Camera: Remidio smartphone fundus camera.
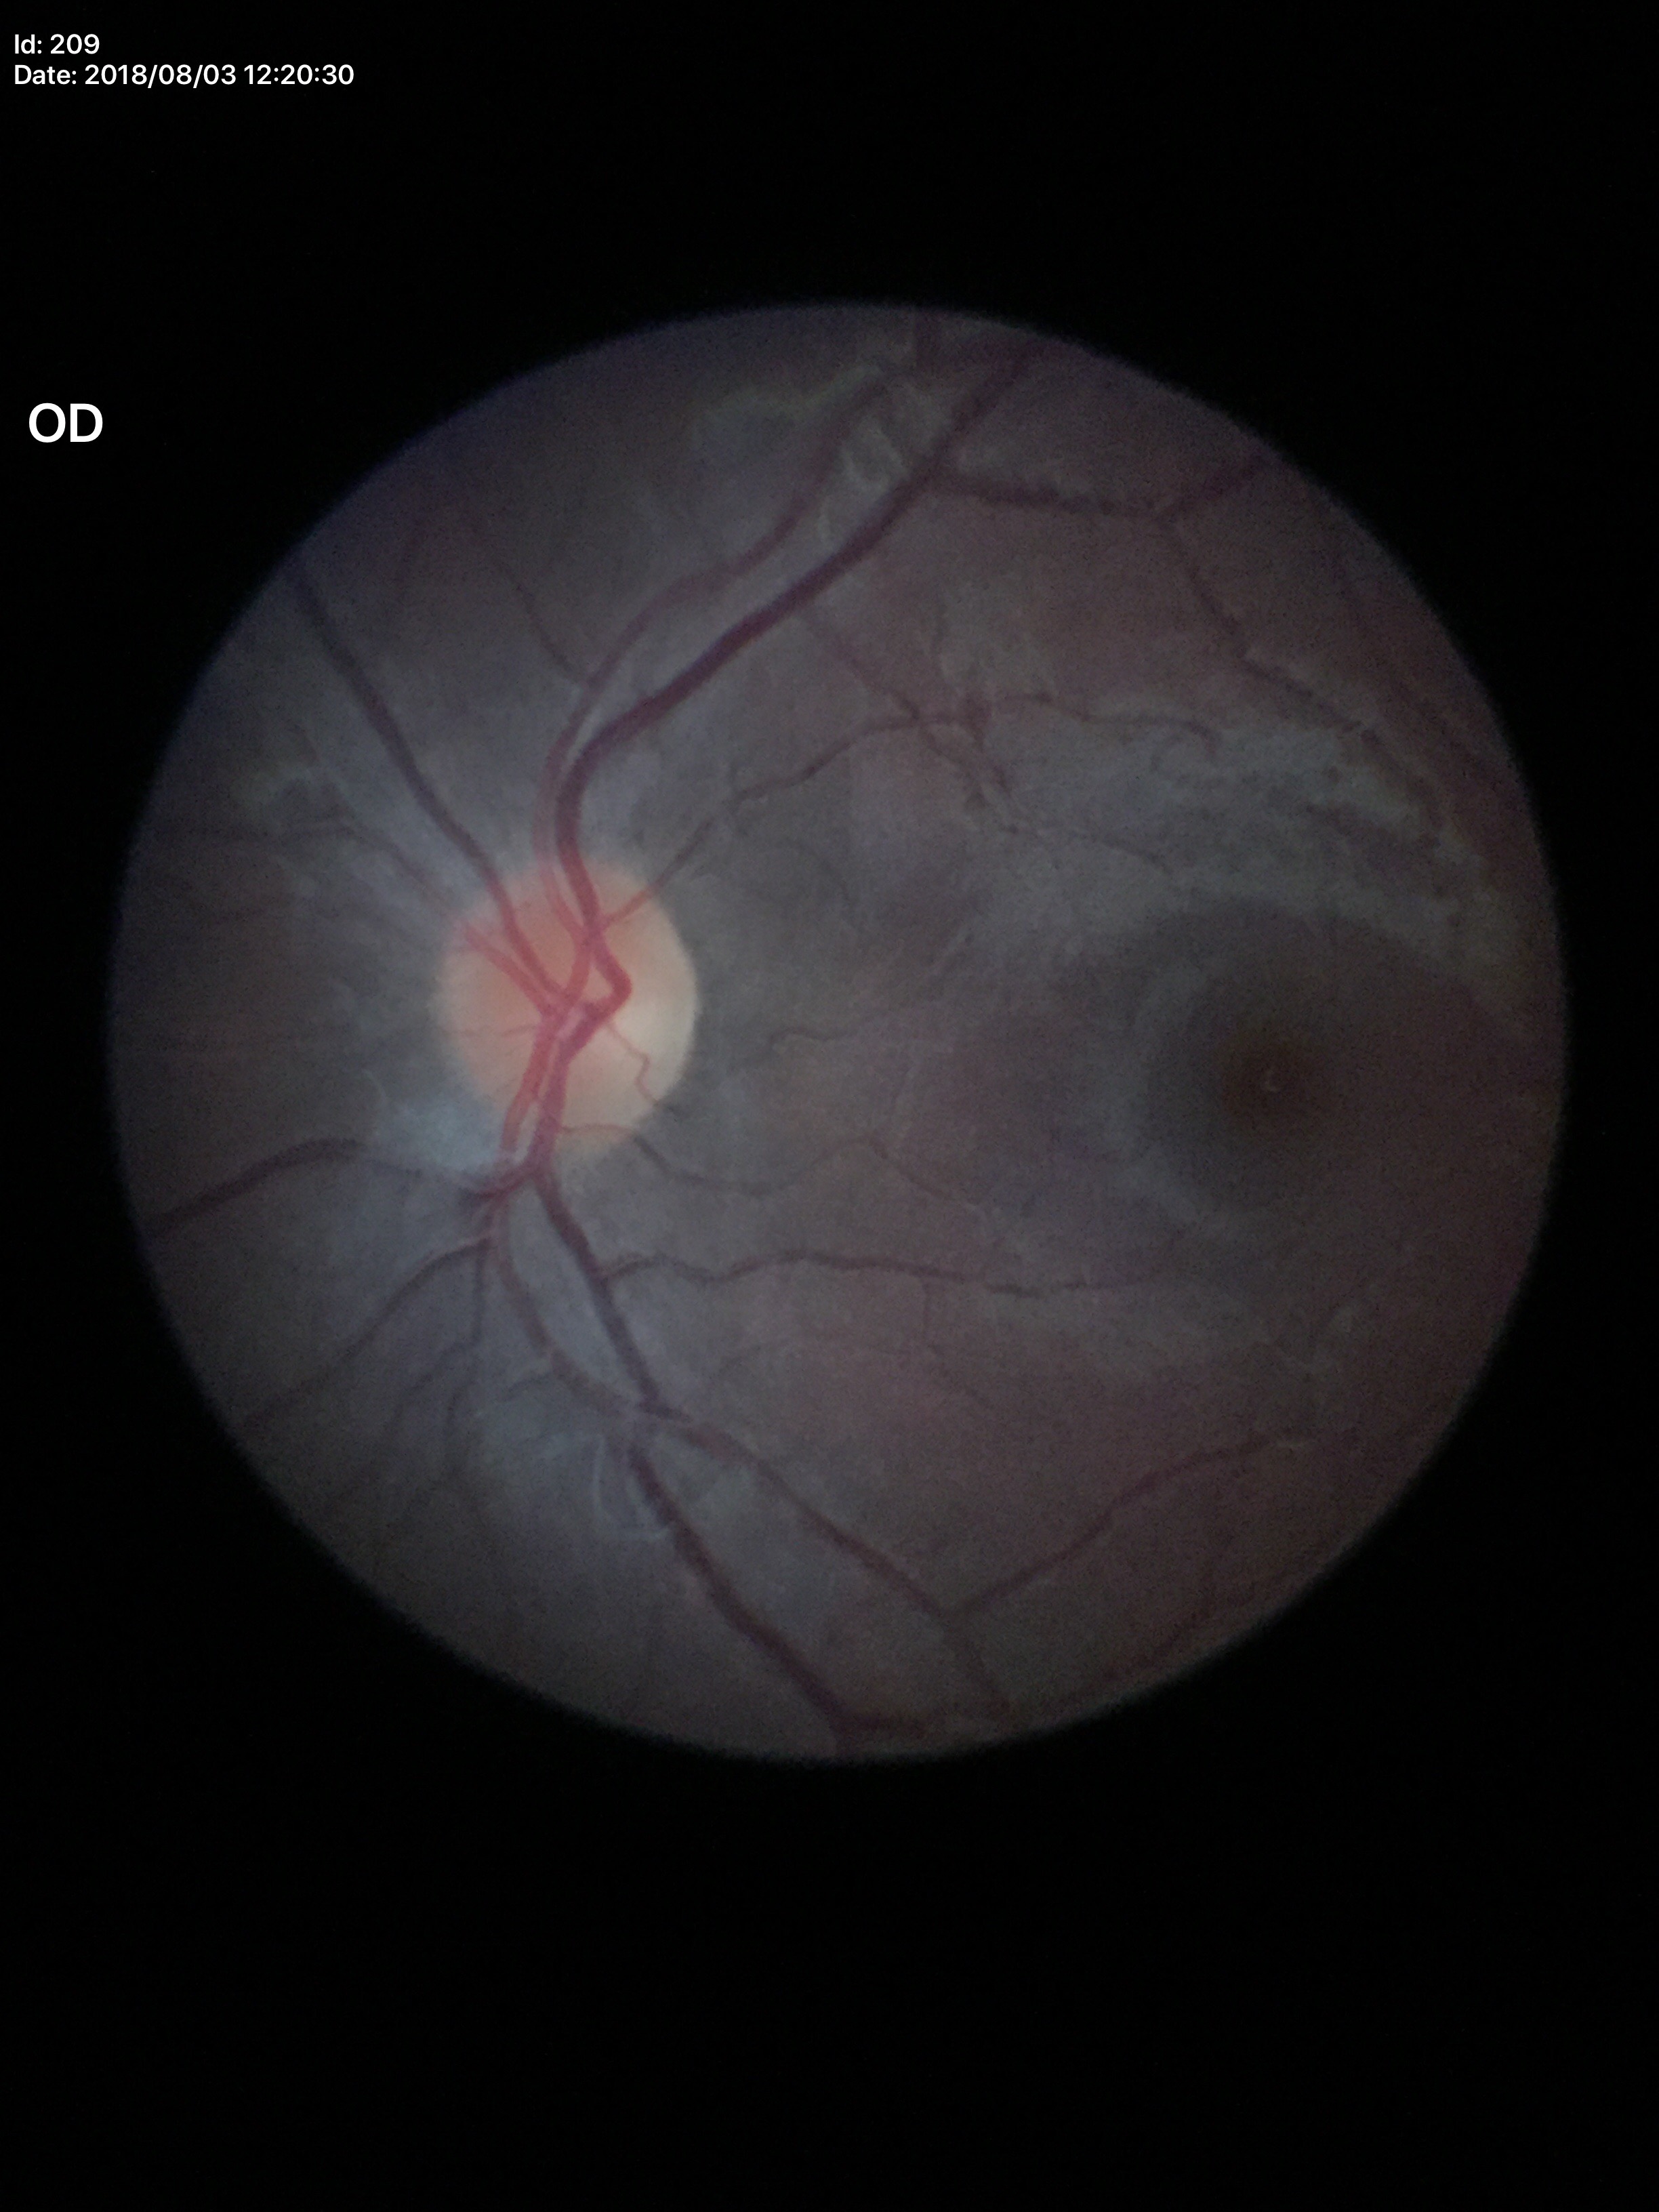
Glaucoma screening: not suspect | horizontal cup-to-disc ratio (HCDR): 0.40 | vertical CDR (VCDR): 0.37.